Retinal fundus photograph
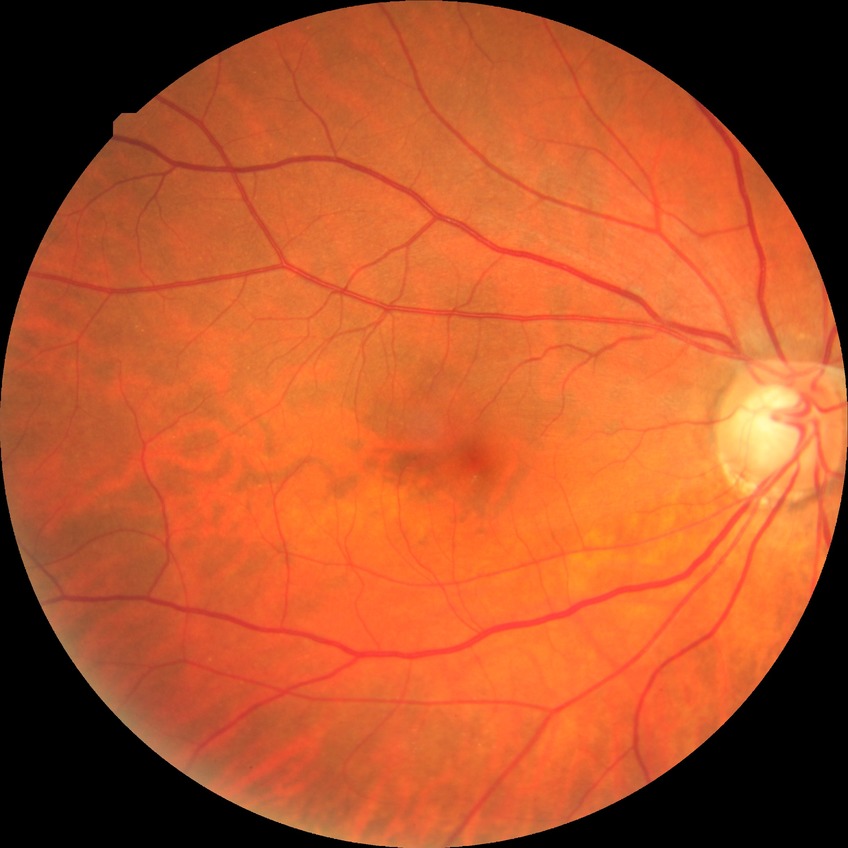
Diabetic retinopathy (DR) is NDR (no diabetic retinopathy).